45-degree field of view:
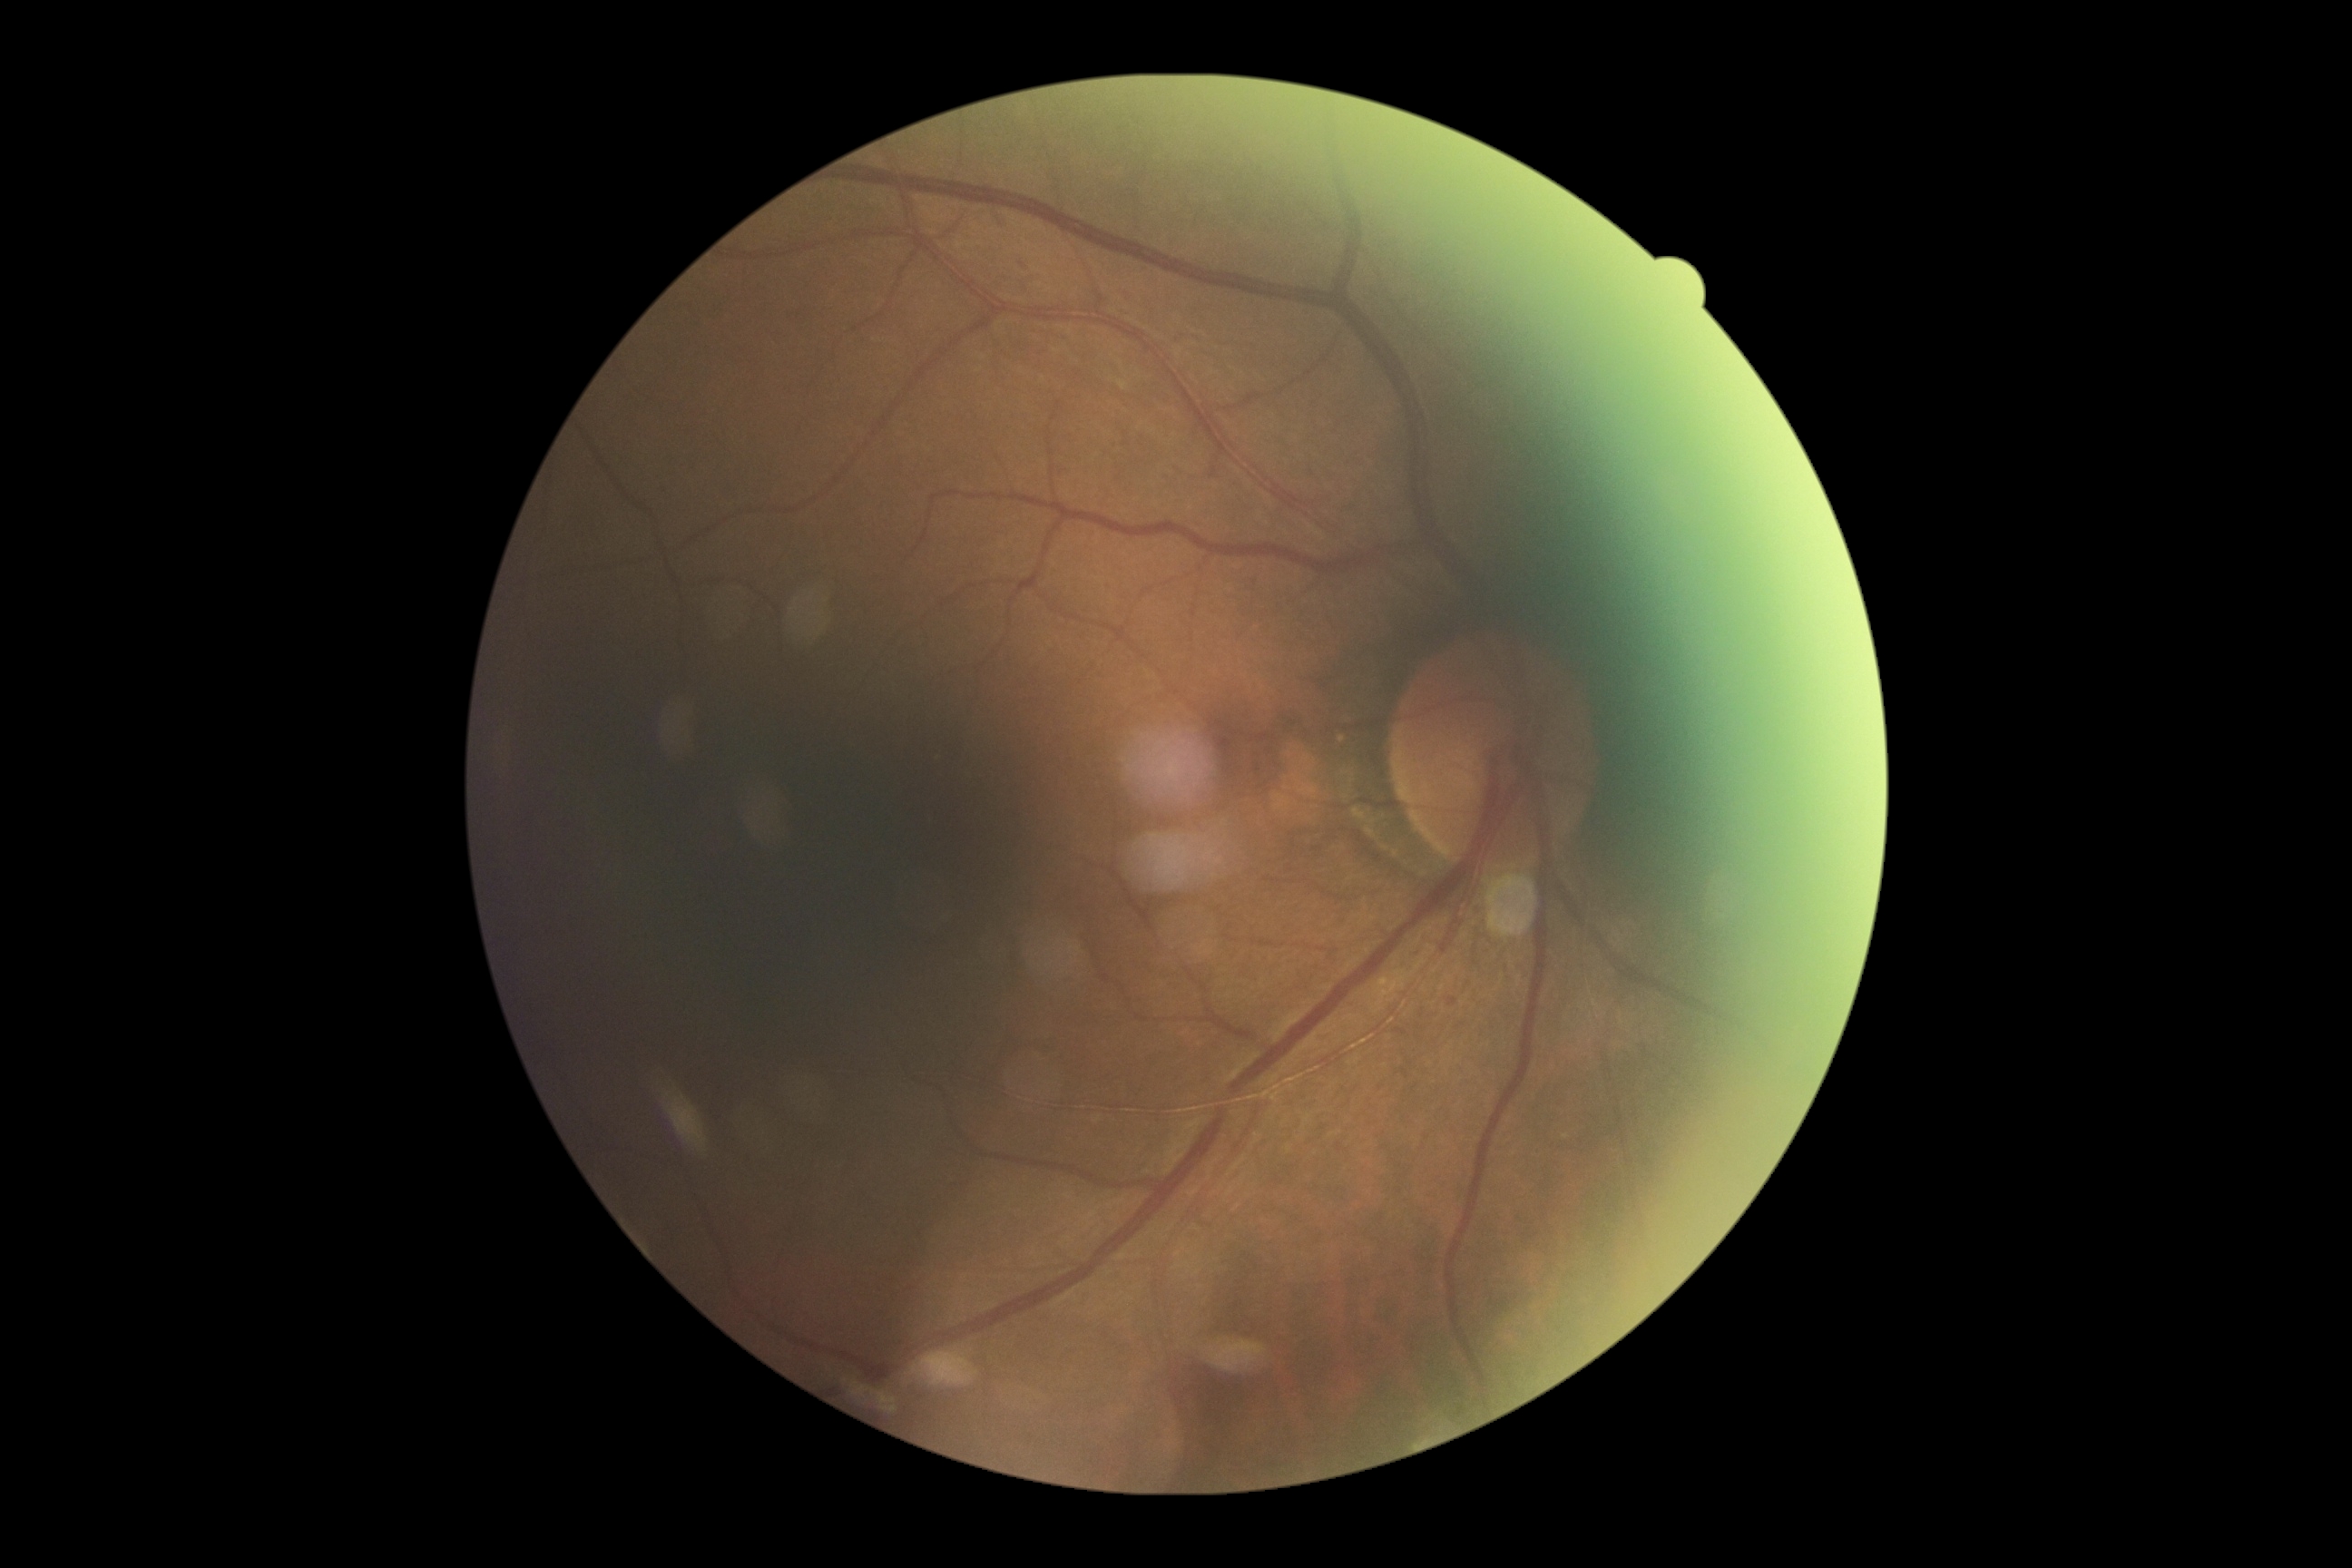 DR is grade 2 (moderate NPDR).